Graded on the modified Davis scale — 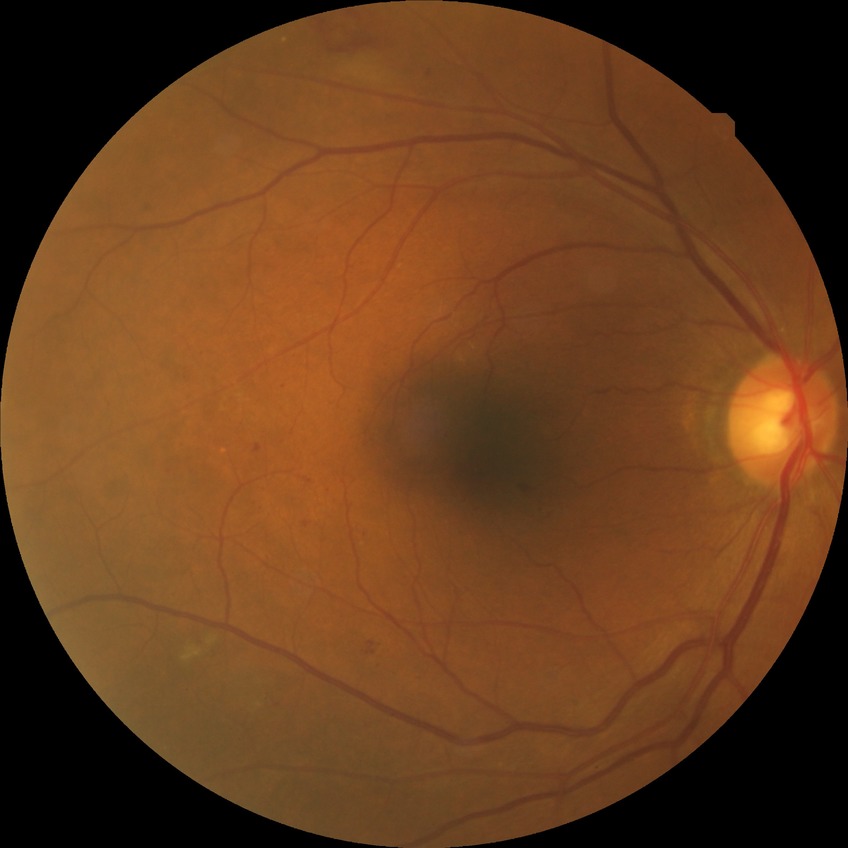

diabetic retinopathy grade@simple diabetic retinopathy.